2352 by 1568 pixels. Fundus photo — 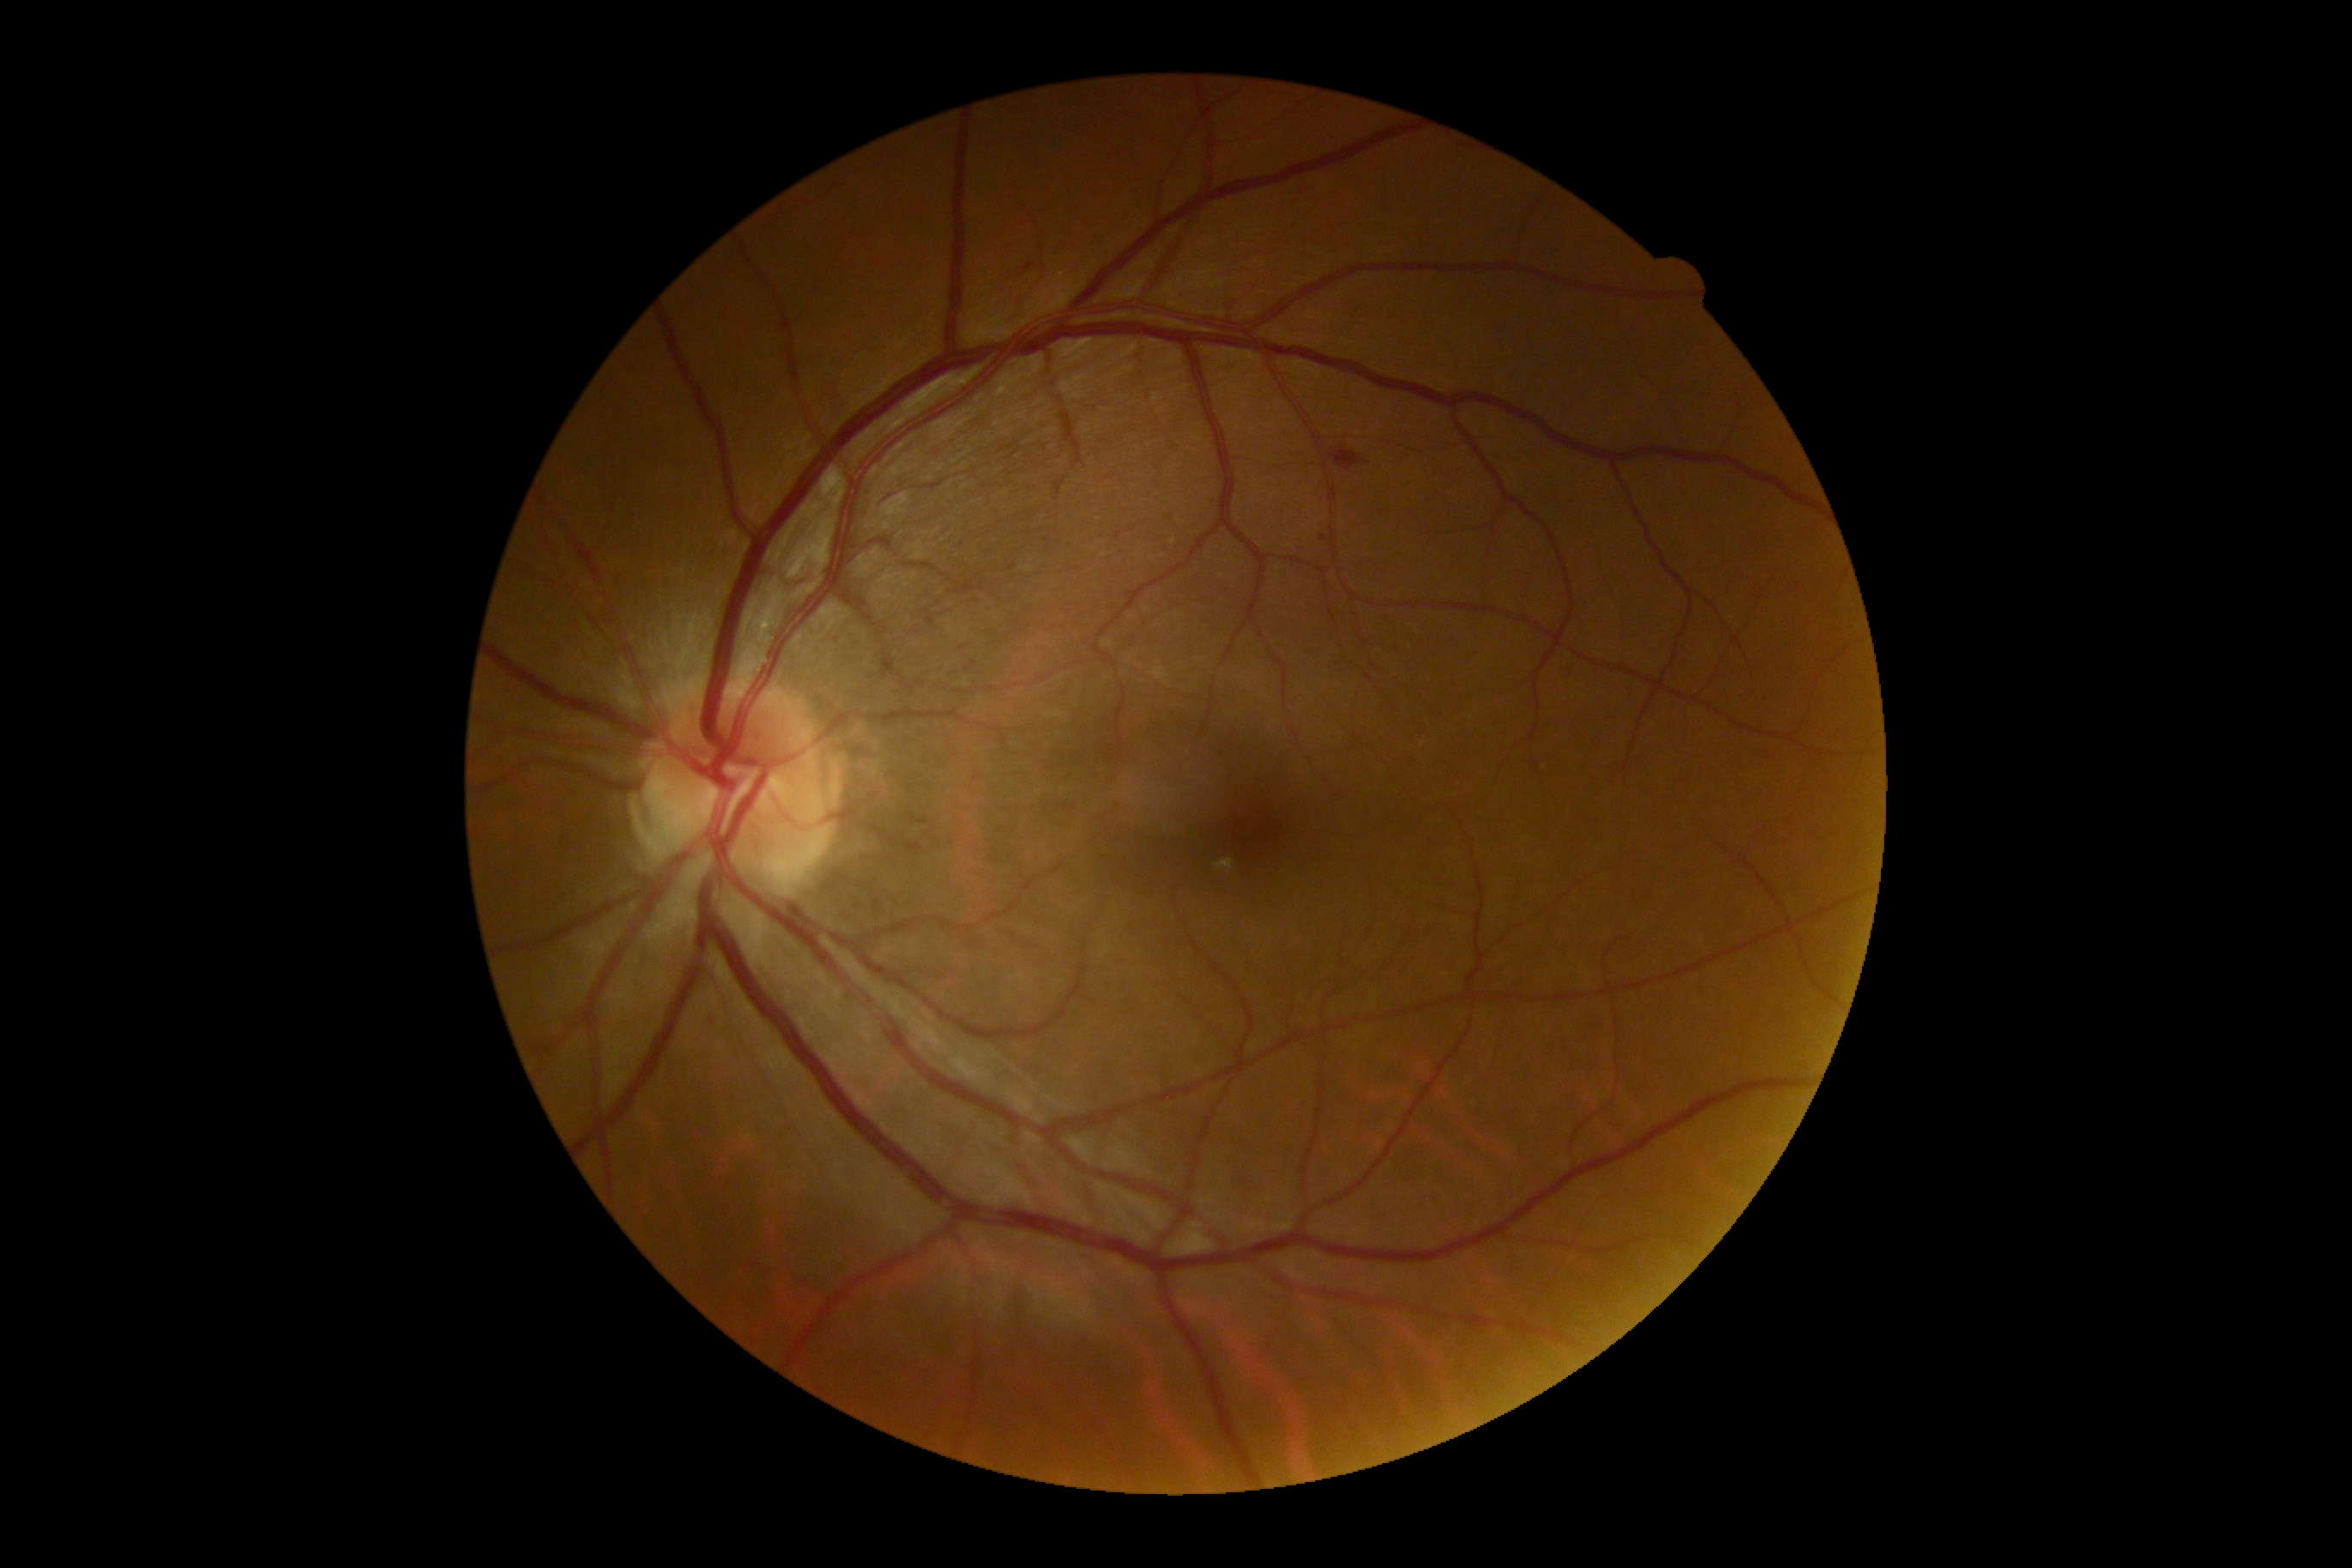

• DR stage: grade 2